CFP. 2352 x 1568 pixels:
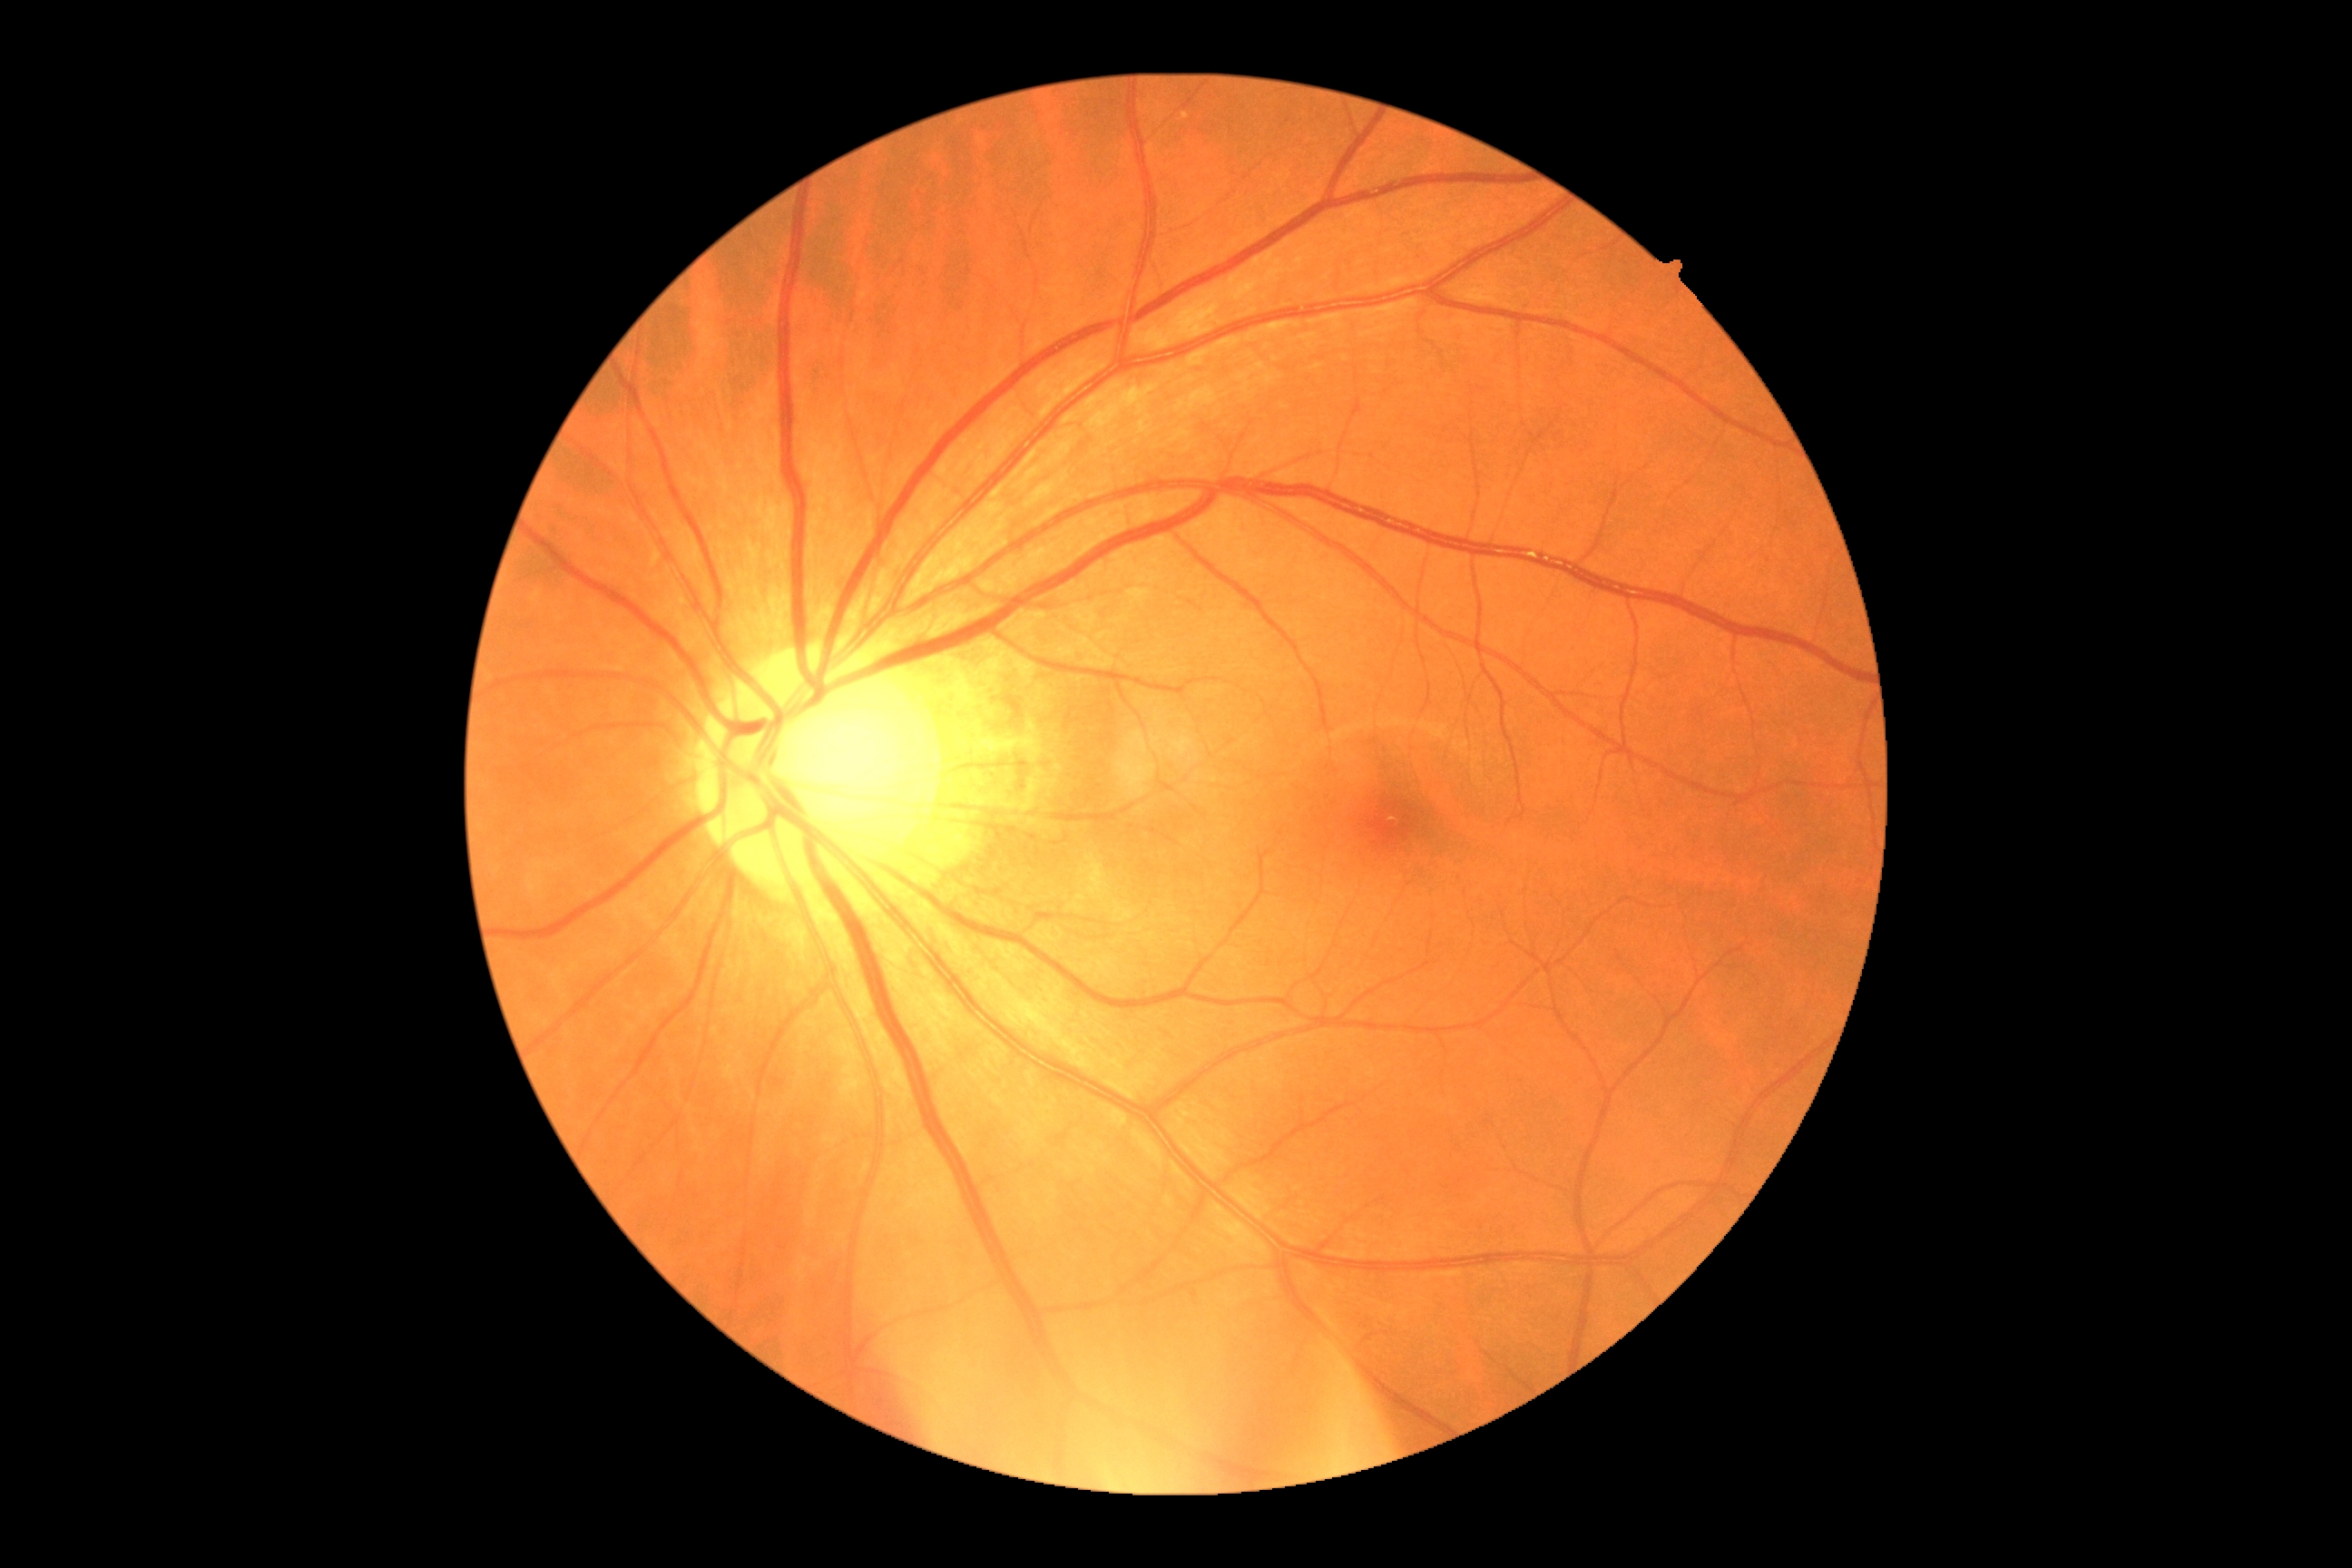 Diabetic retinopathy (DR): 0/4.